Wide-field fundus photograph from neonatal ROP screening.
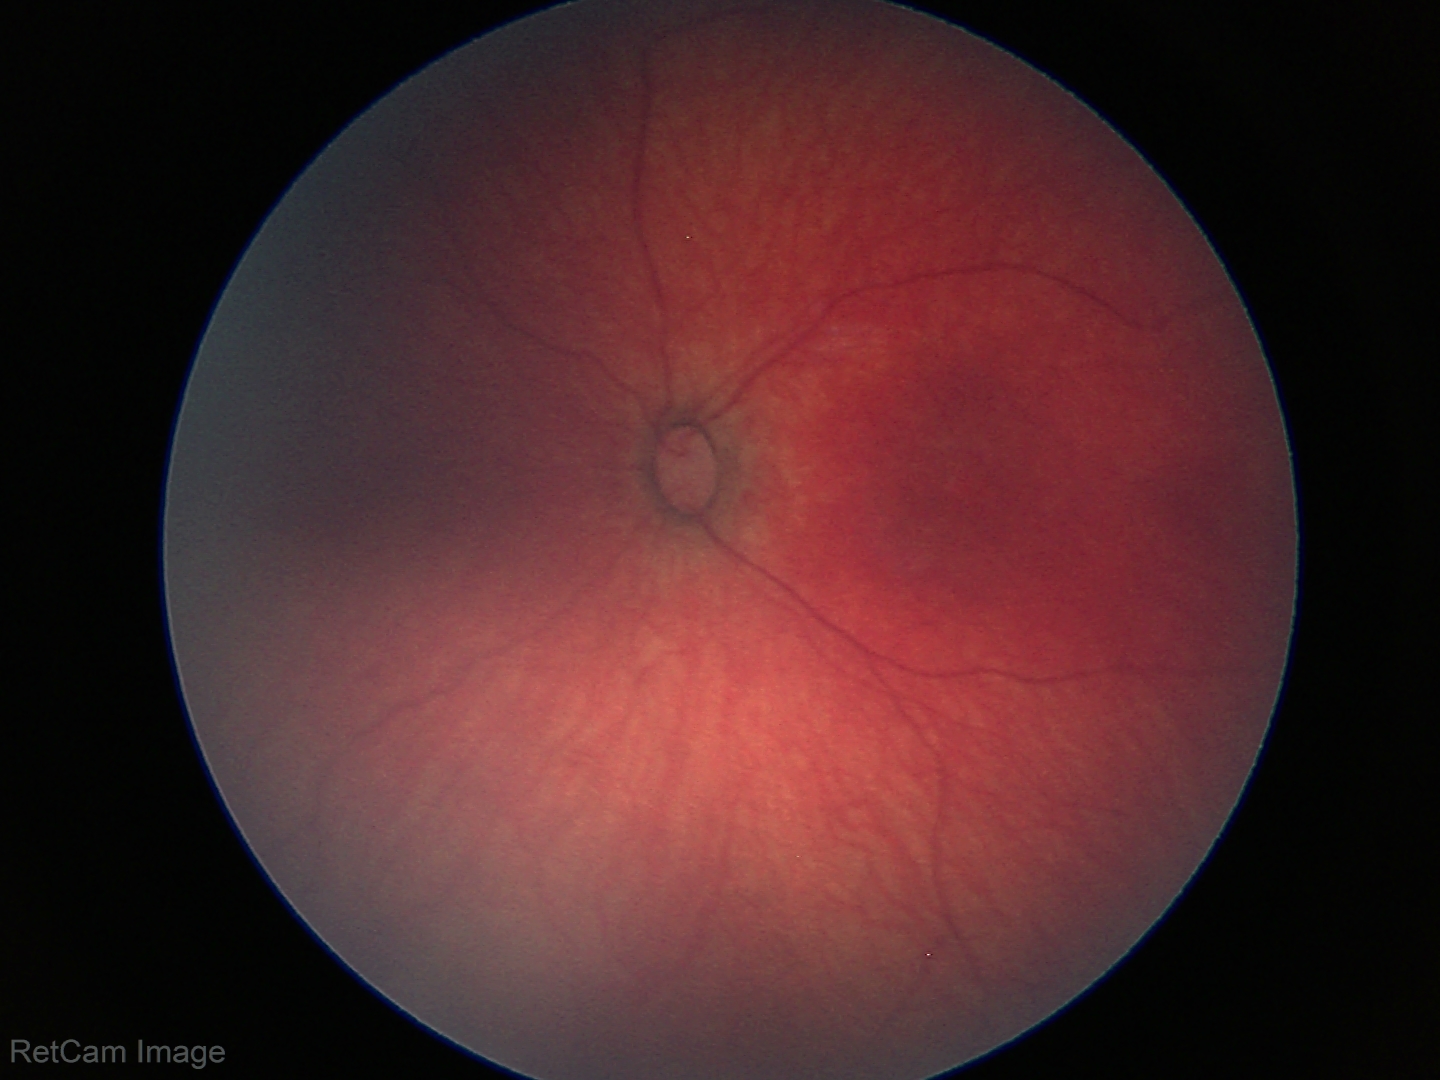

No retinal pathology identified on screening.